Wide-field contact fundus photograph of an infant · 1240x1240px:
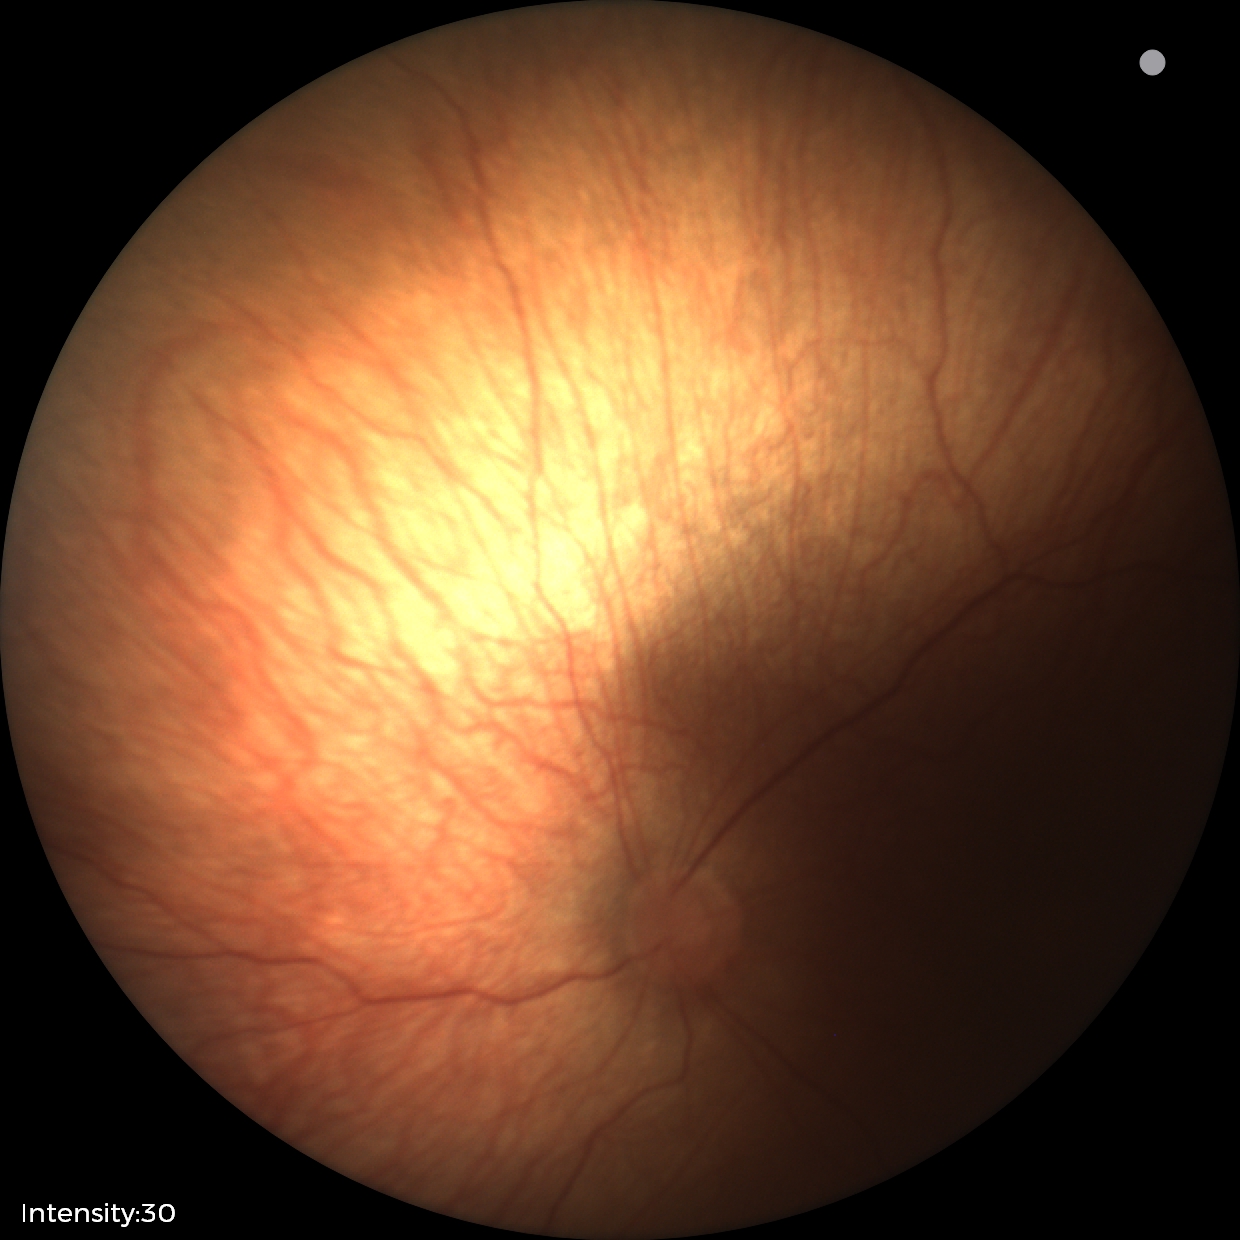

Screening examination diagnosed as physiological.